Image size 1504x1000 — 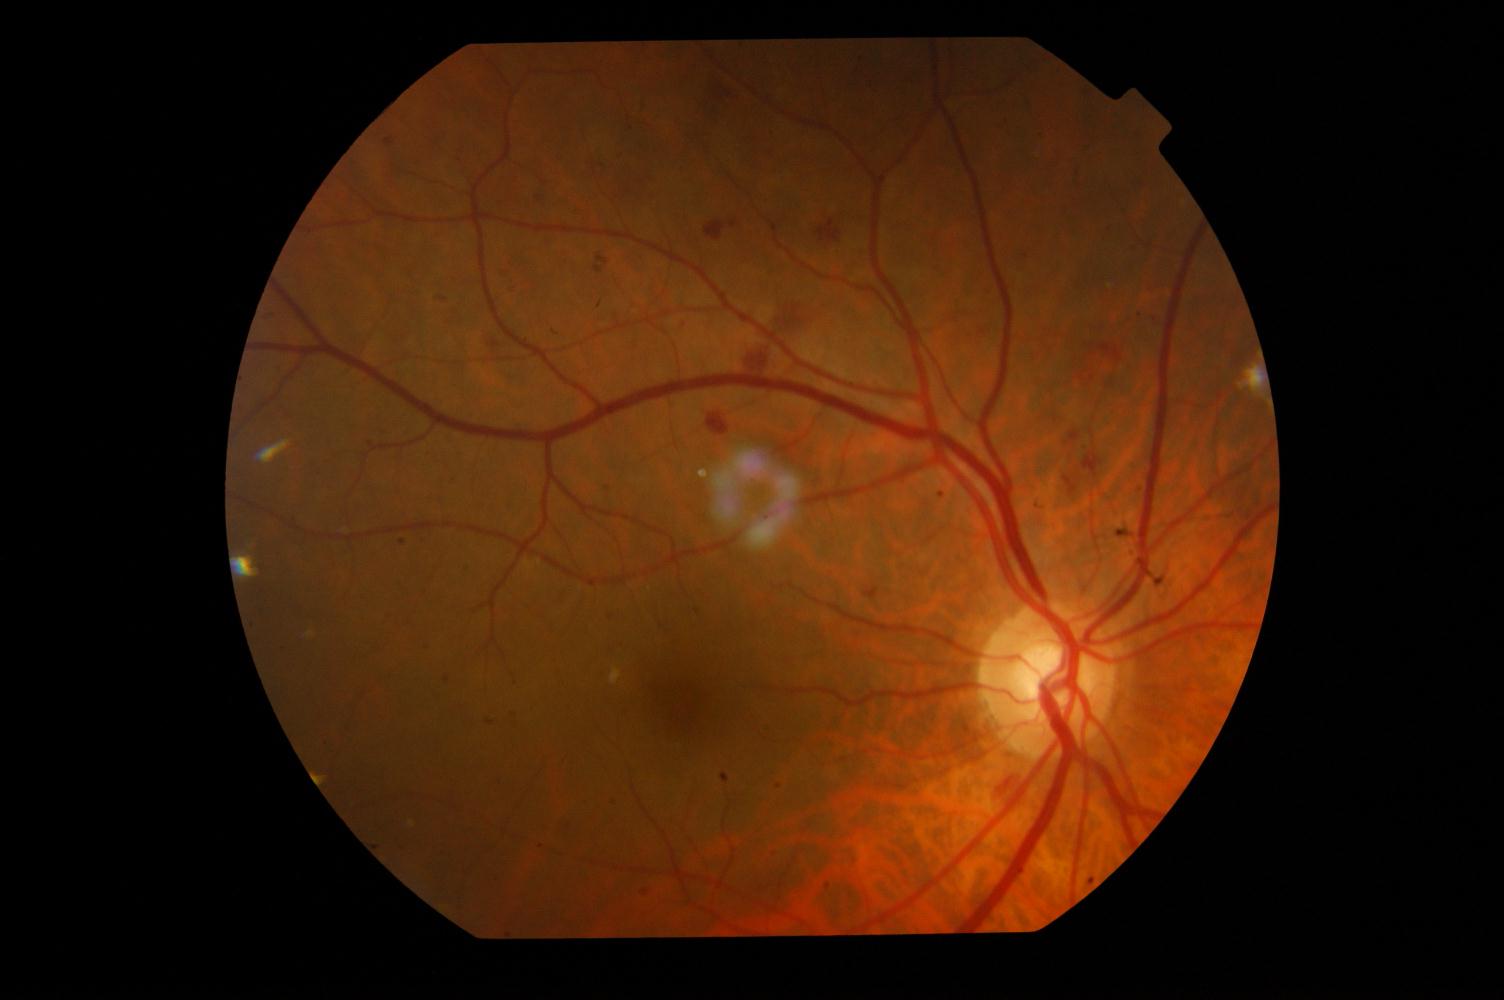 Pathology: DR (diabetic retinopathy).